100° field of view (Phoenix ICON). Wide-field fundus photograph of an infant: 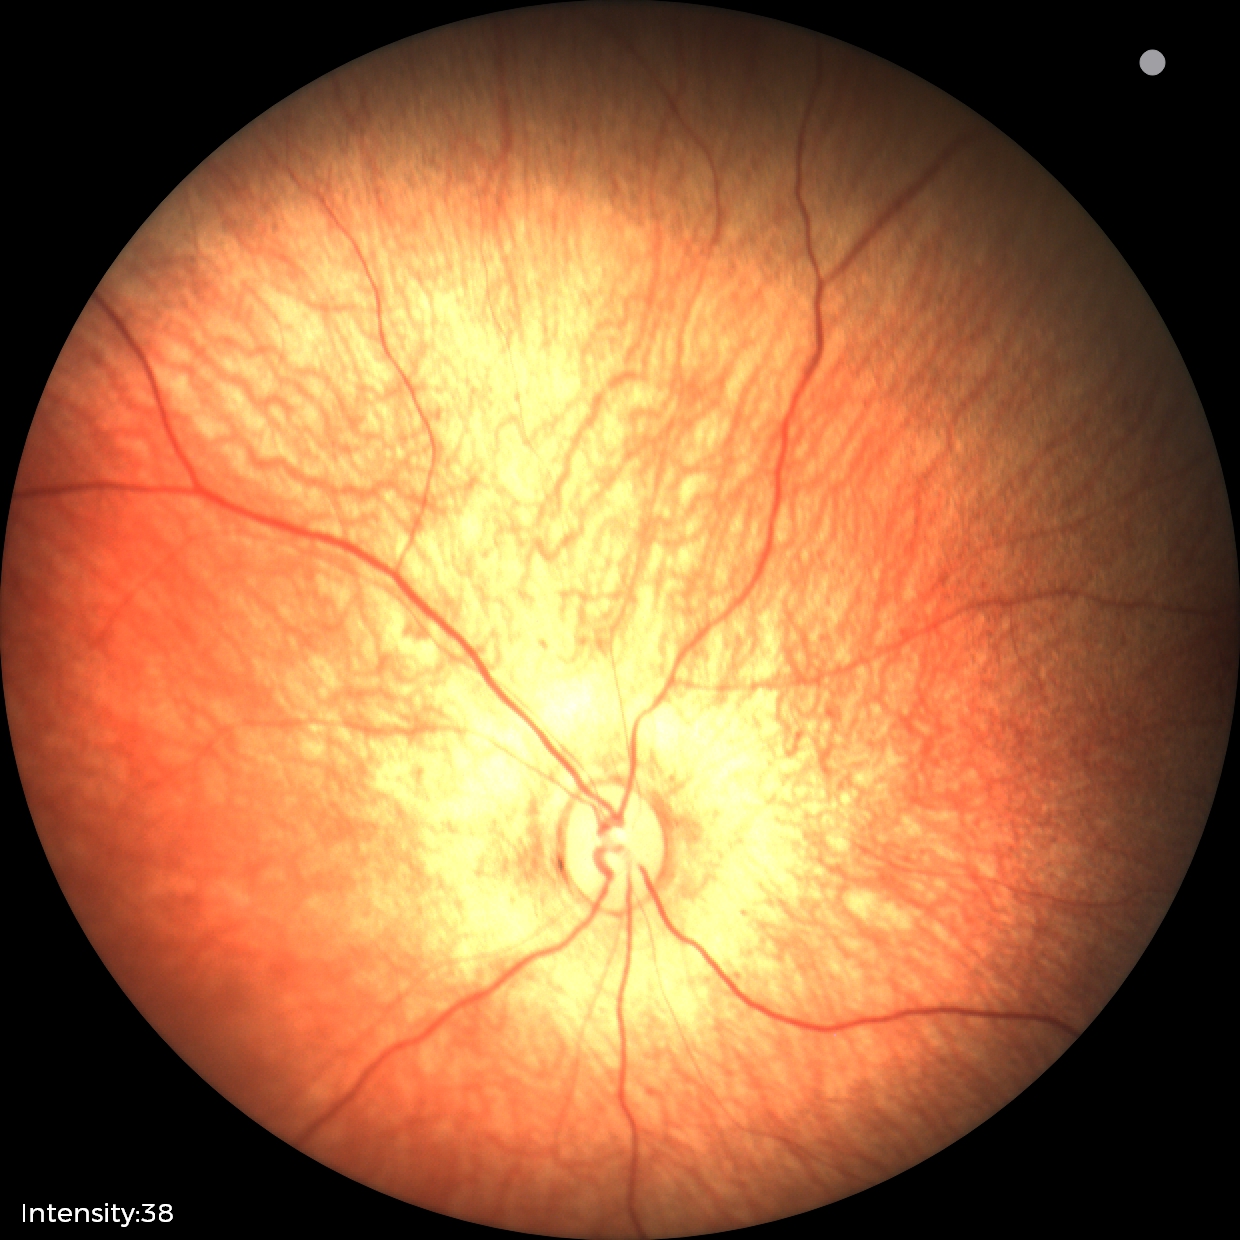

Examination with physiological retinal findings.